1932x1932; FOV: 45 degrees; retinal fundus photograph: 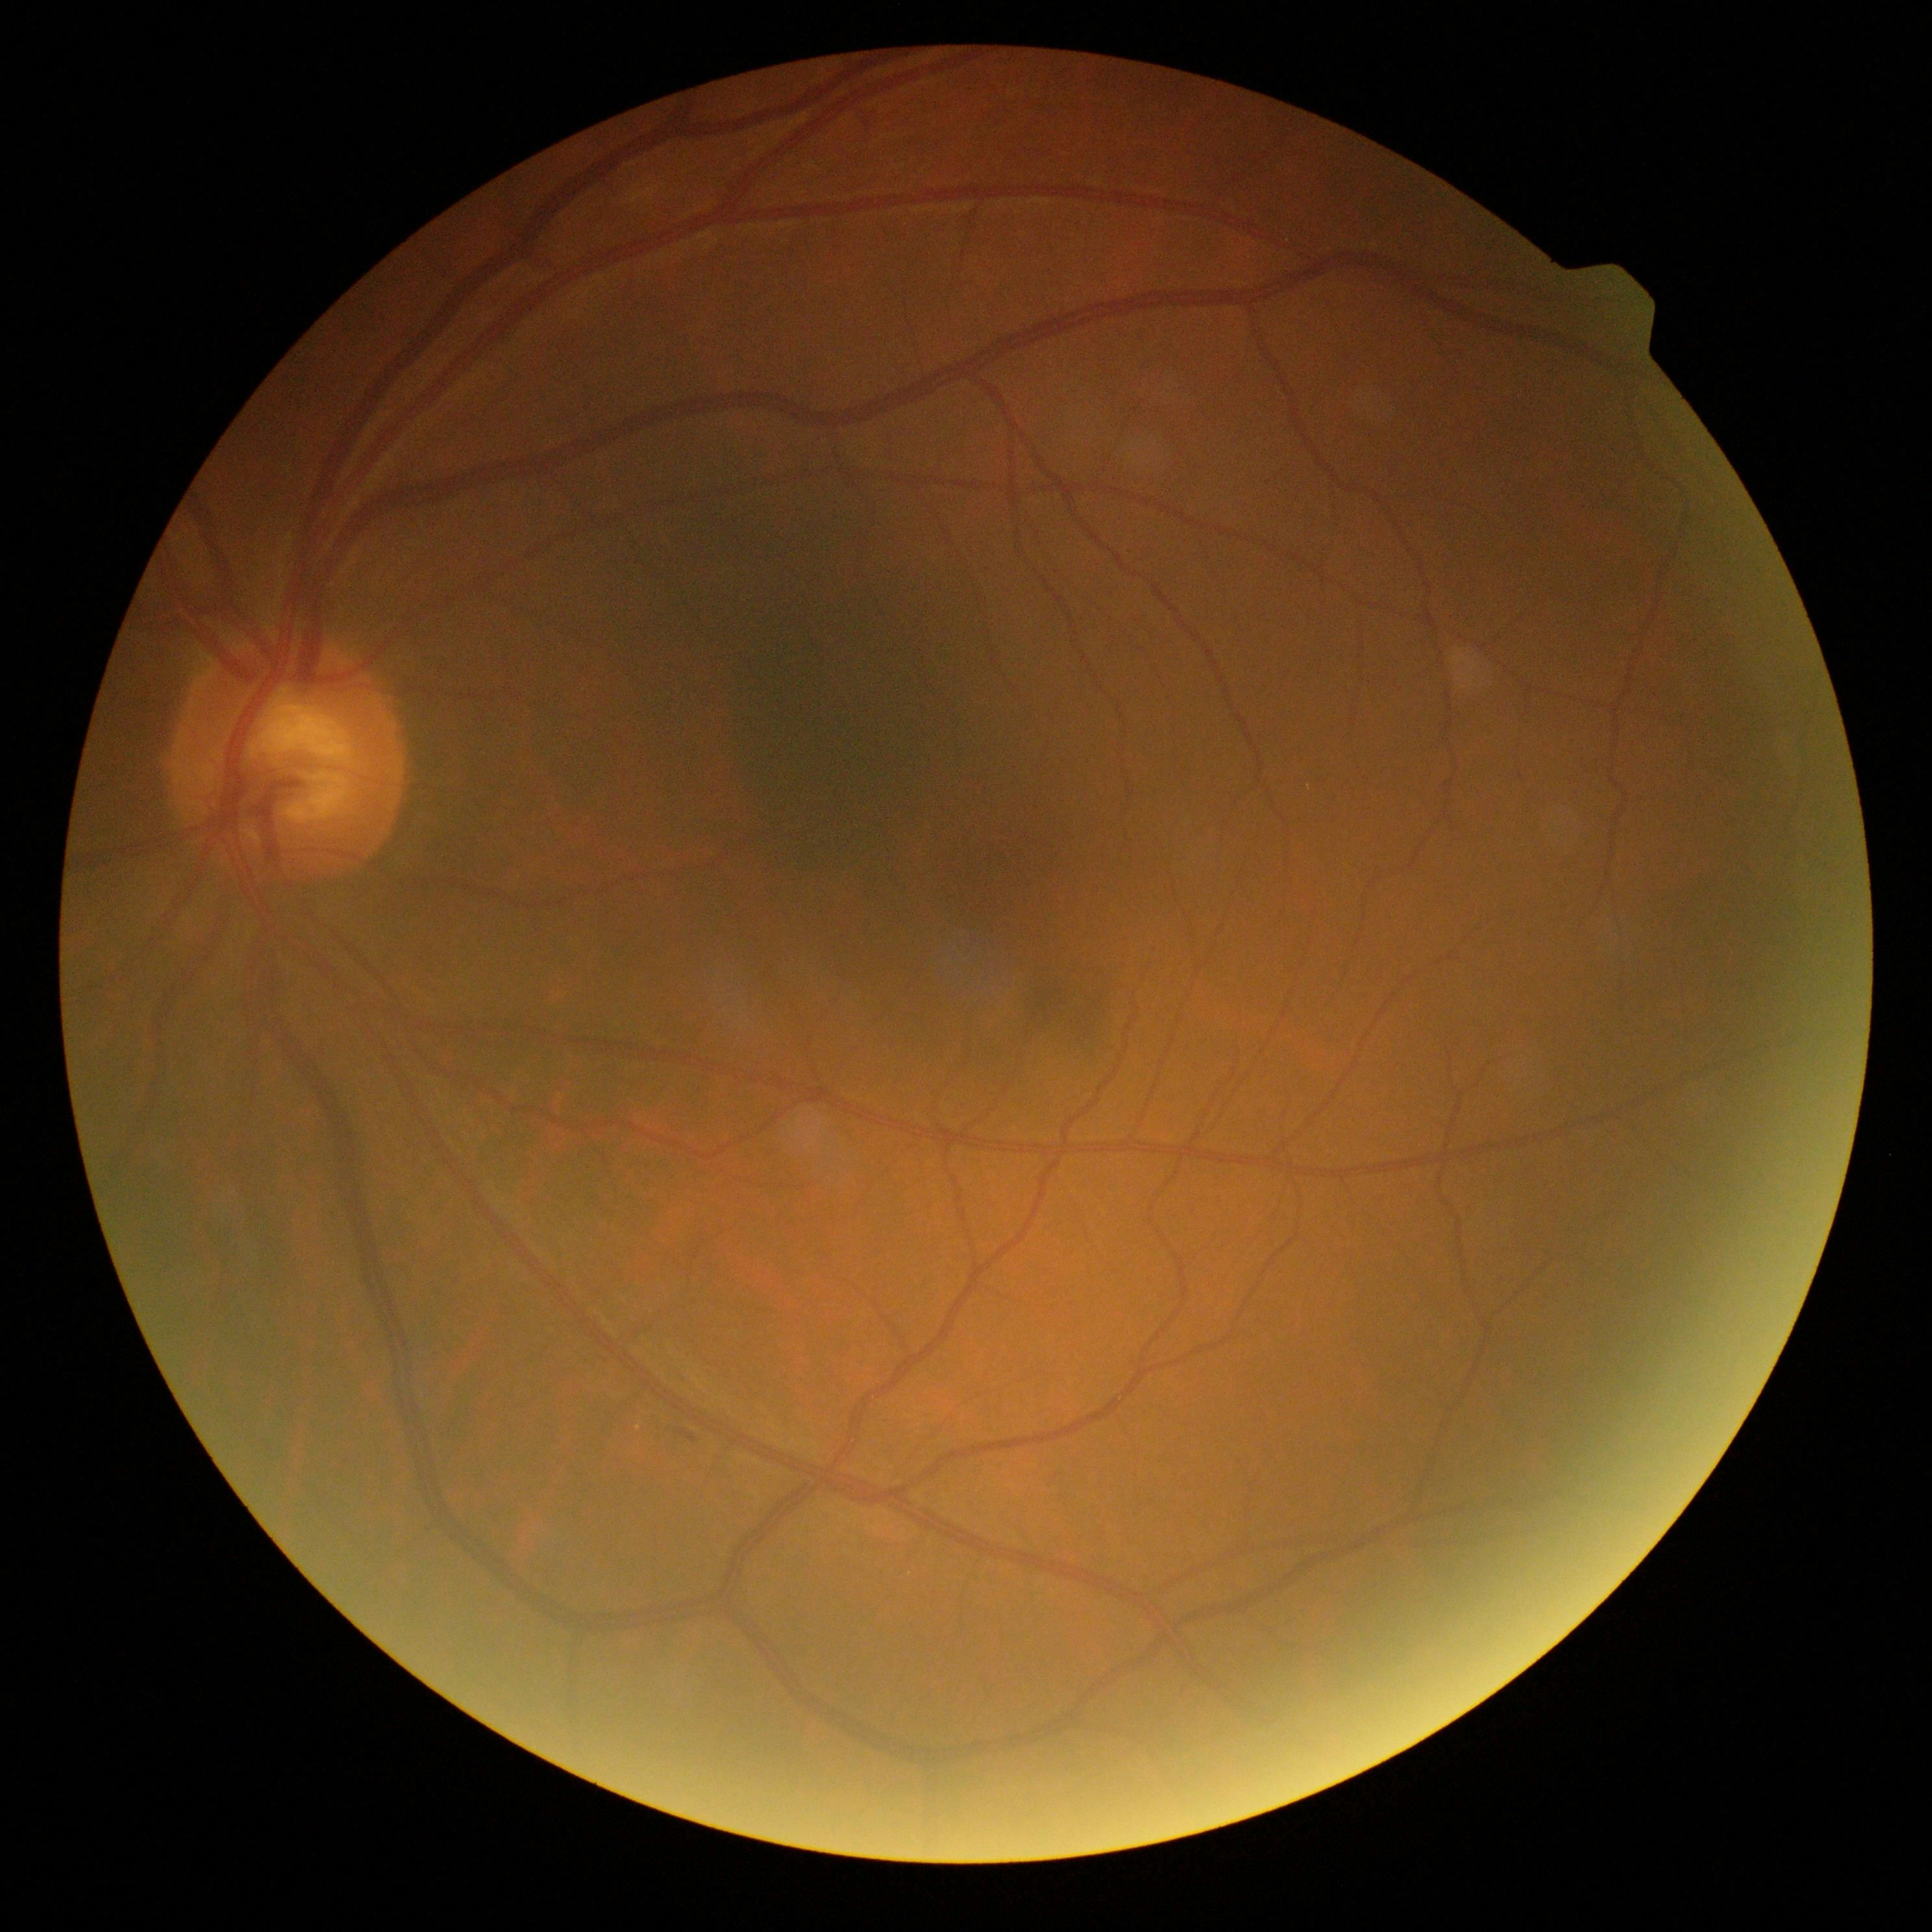 Diabetic retinopathy (DR) is 2/4.
DR class: non-proliferative diabetic retinopathy.